Posterior pole color fundus photograph; 45° FOV; NIDEK AFC-230 fundus camera; 848 by 848 pixels.
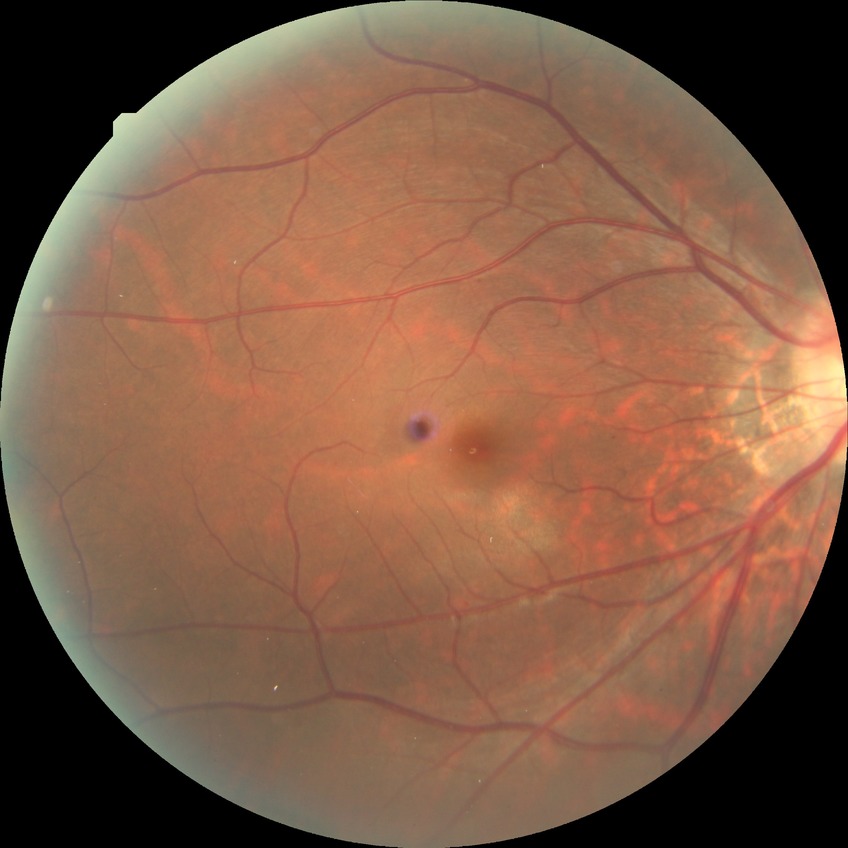

* modified Davis classification — simple diabetic retinopathy